Wide-field contact fundus photograph of an infant.
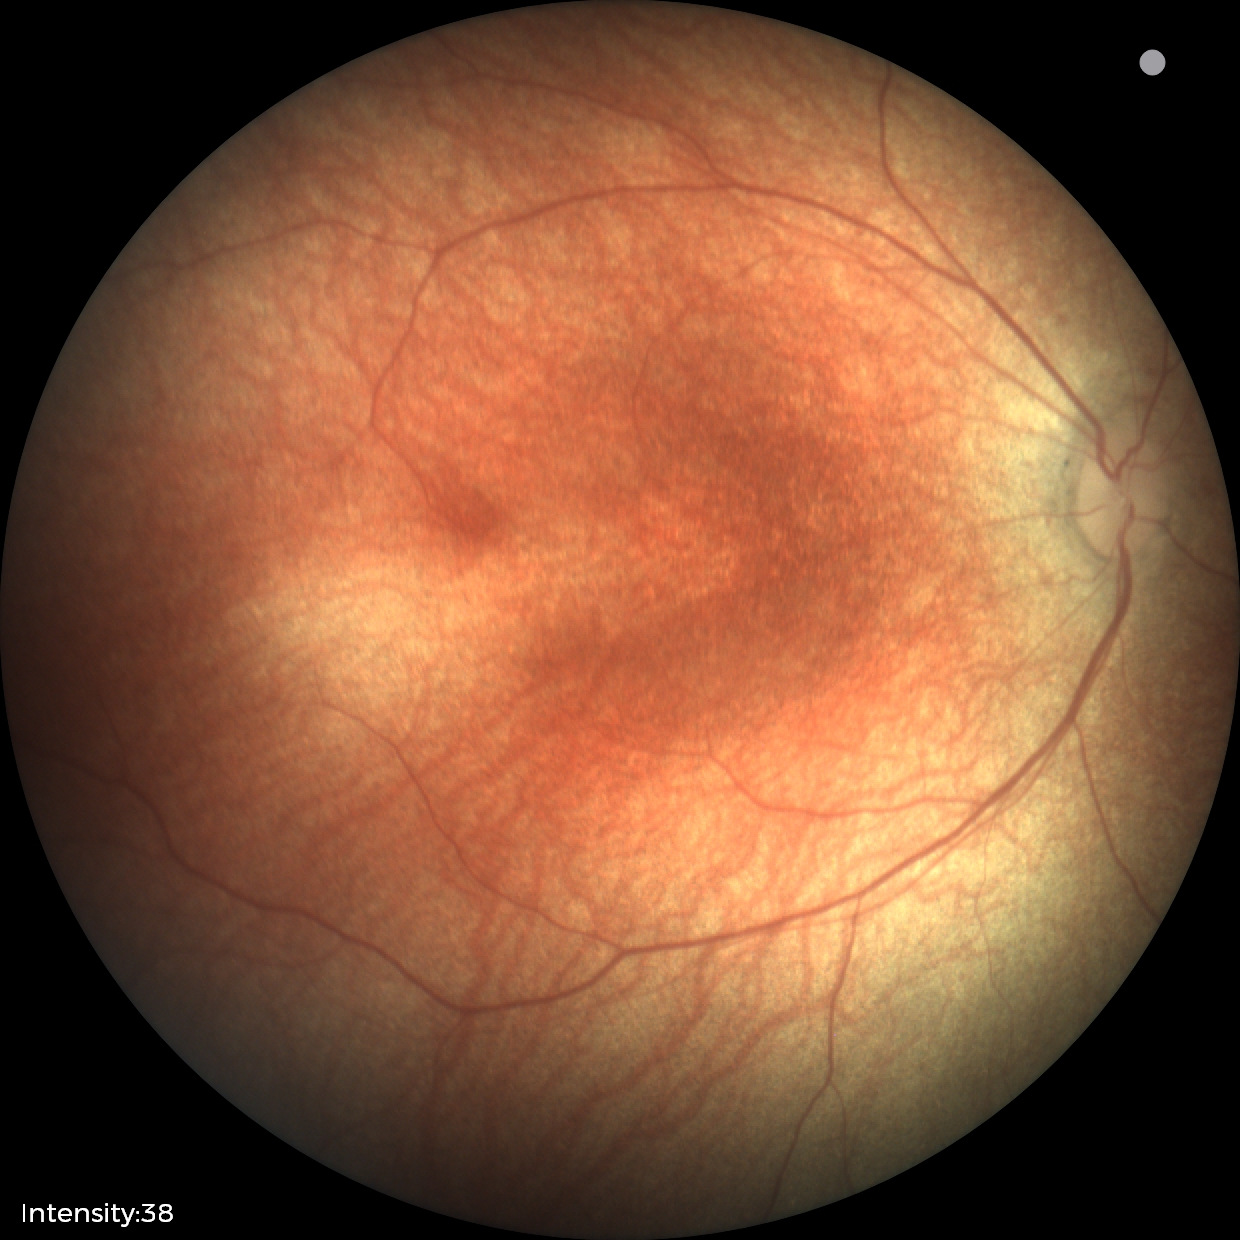
Screening examination diagnosed as physiological.